45 degree fundus photograph:
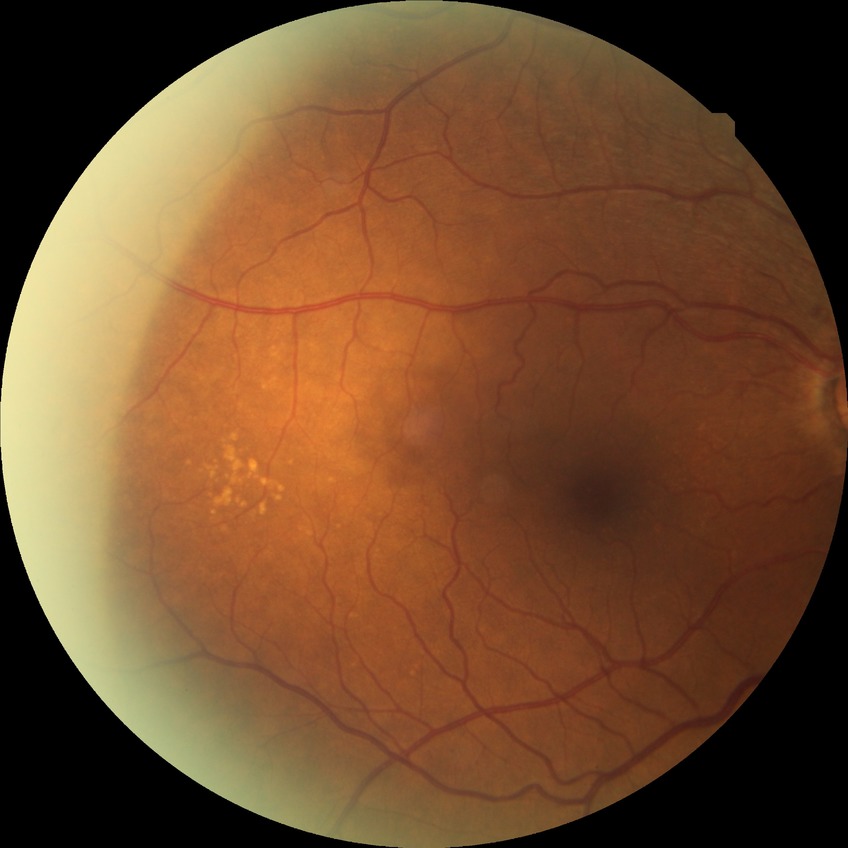 Modified Davis classification is no diabetic retinopathy.